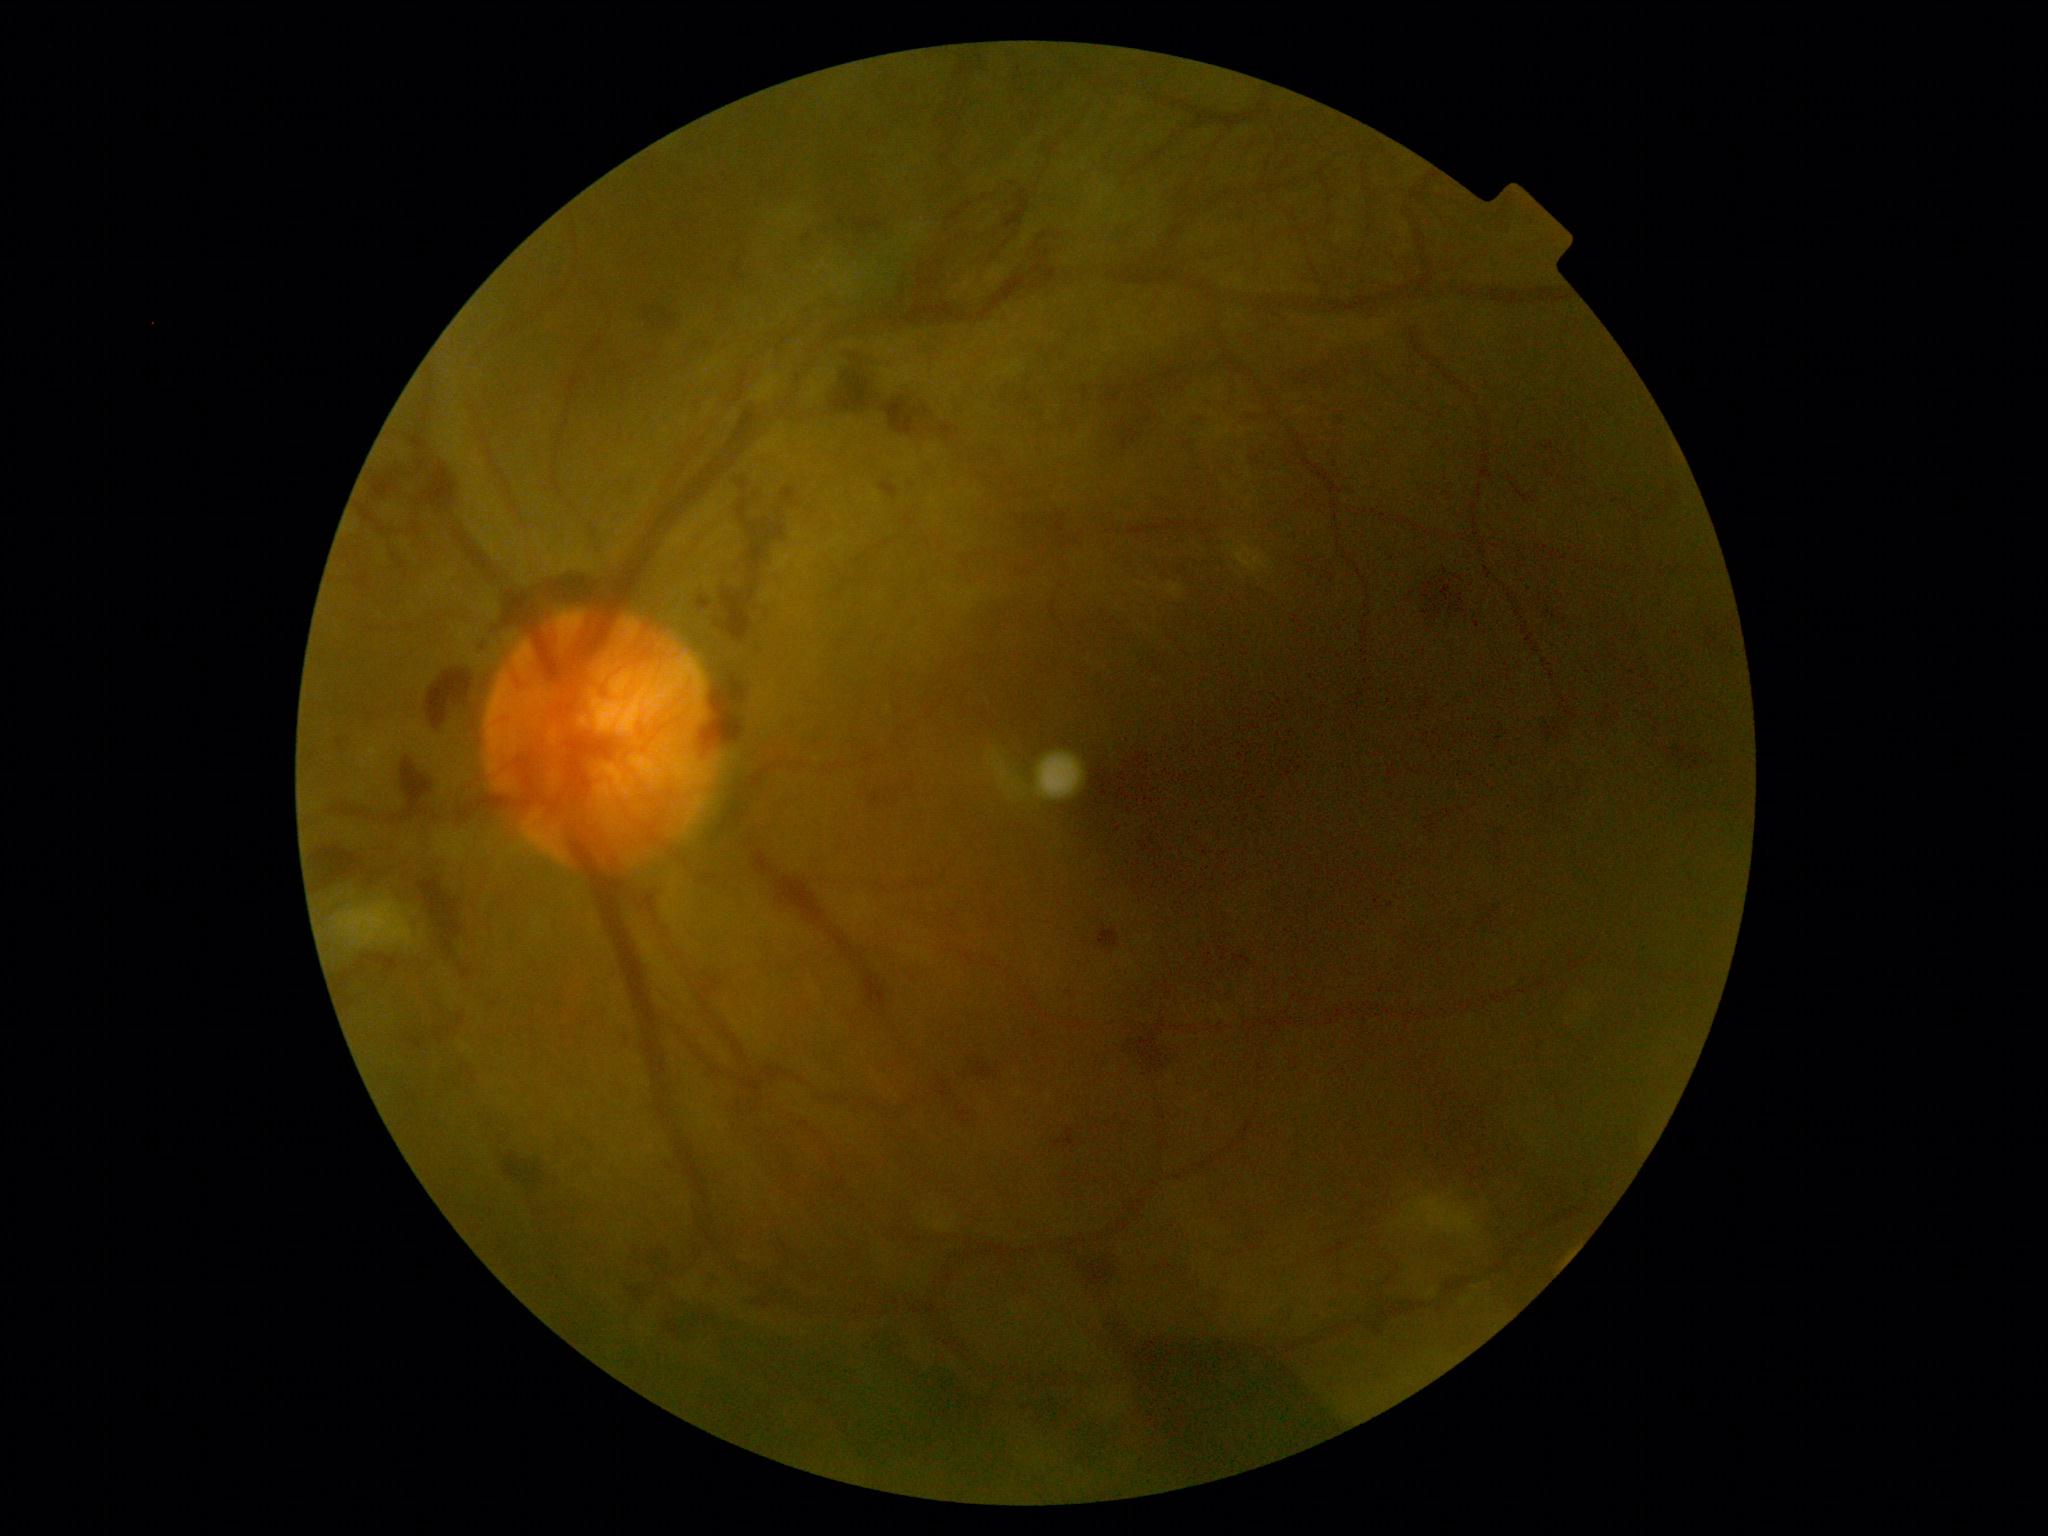 DR class = proliferative diabetic retinopathy, DR = grade 4 (PDR).